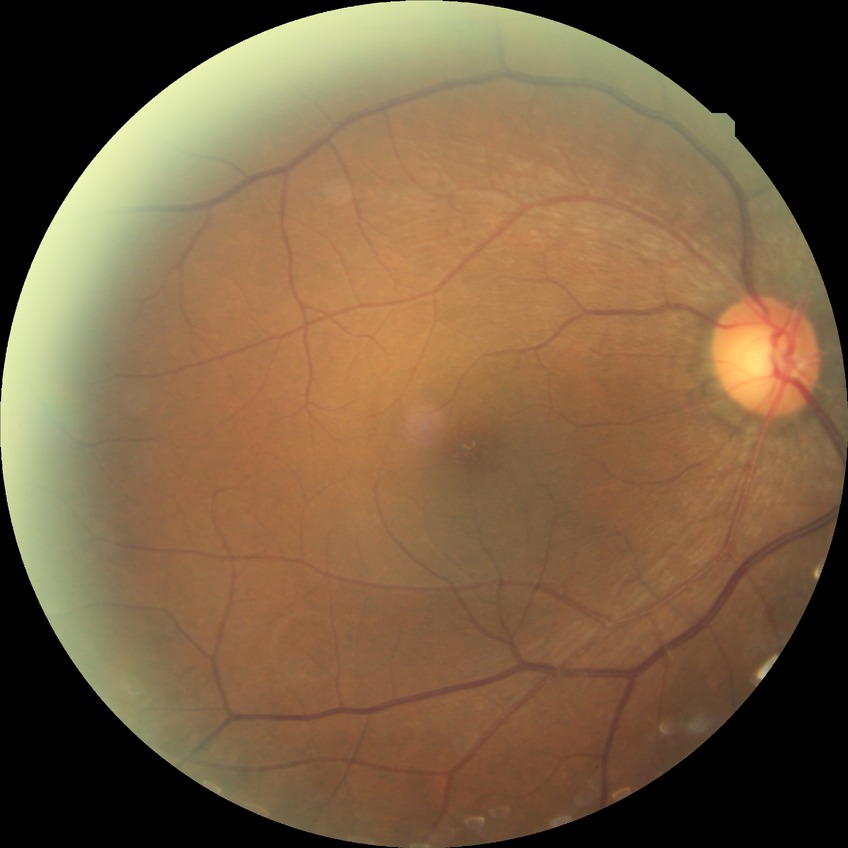 retinopathy stage: no diabetic retinopathy.